Color fundus photograph · 45-degree field of view · 2352x1568
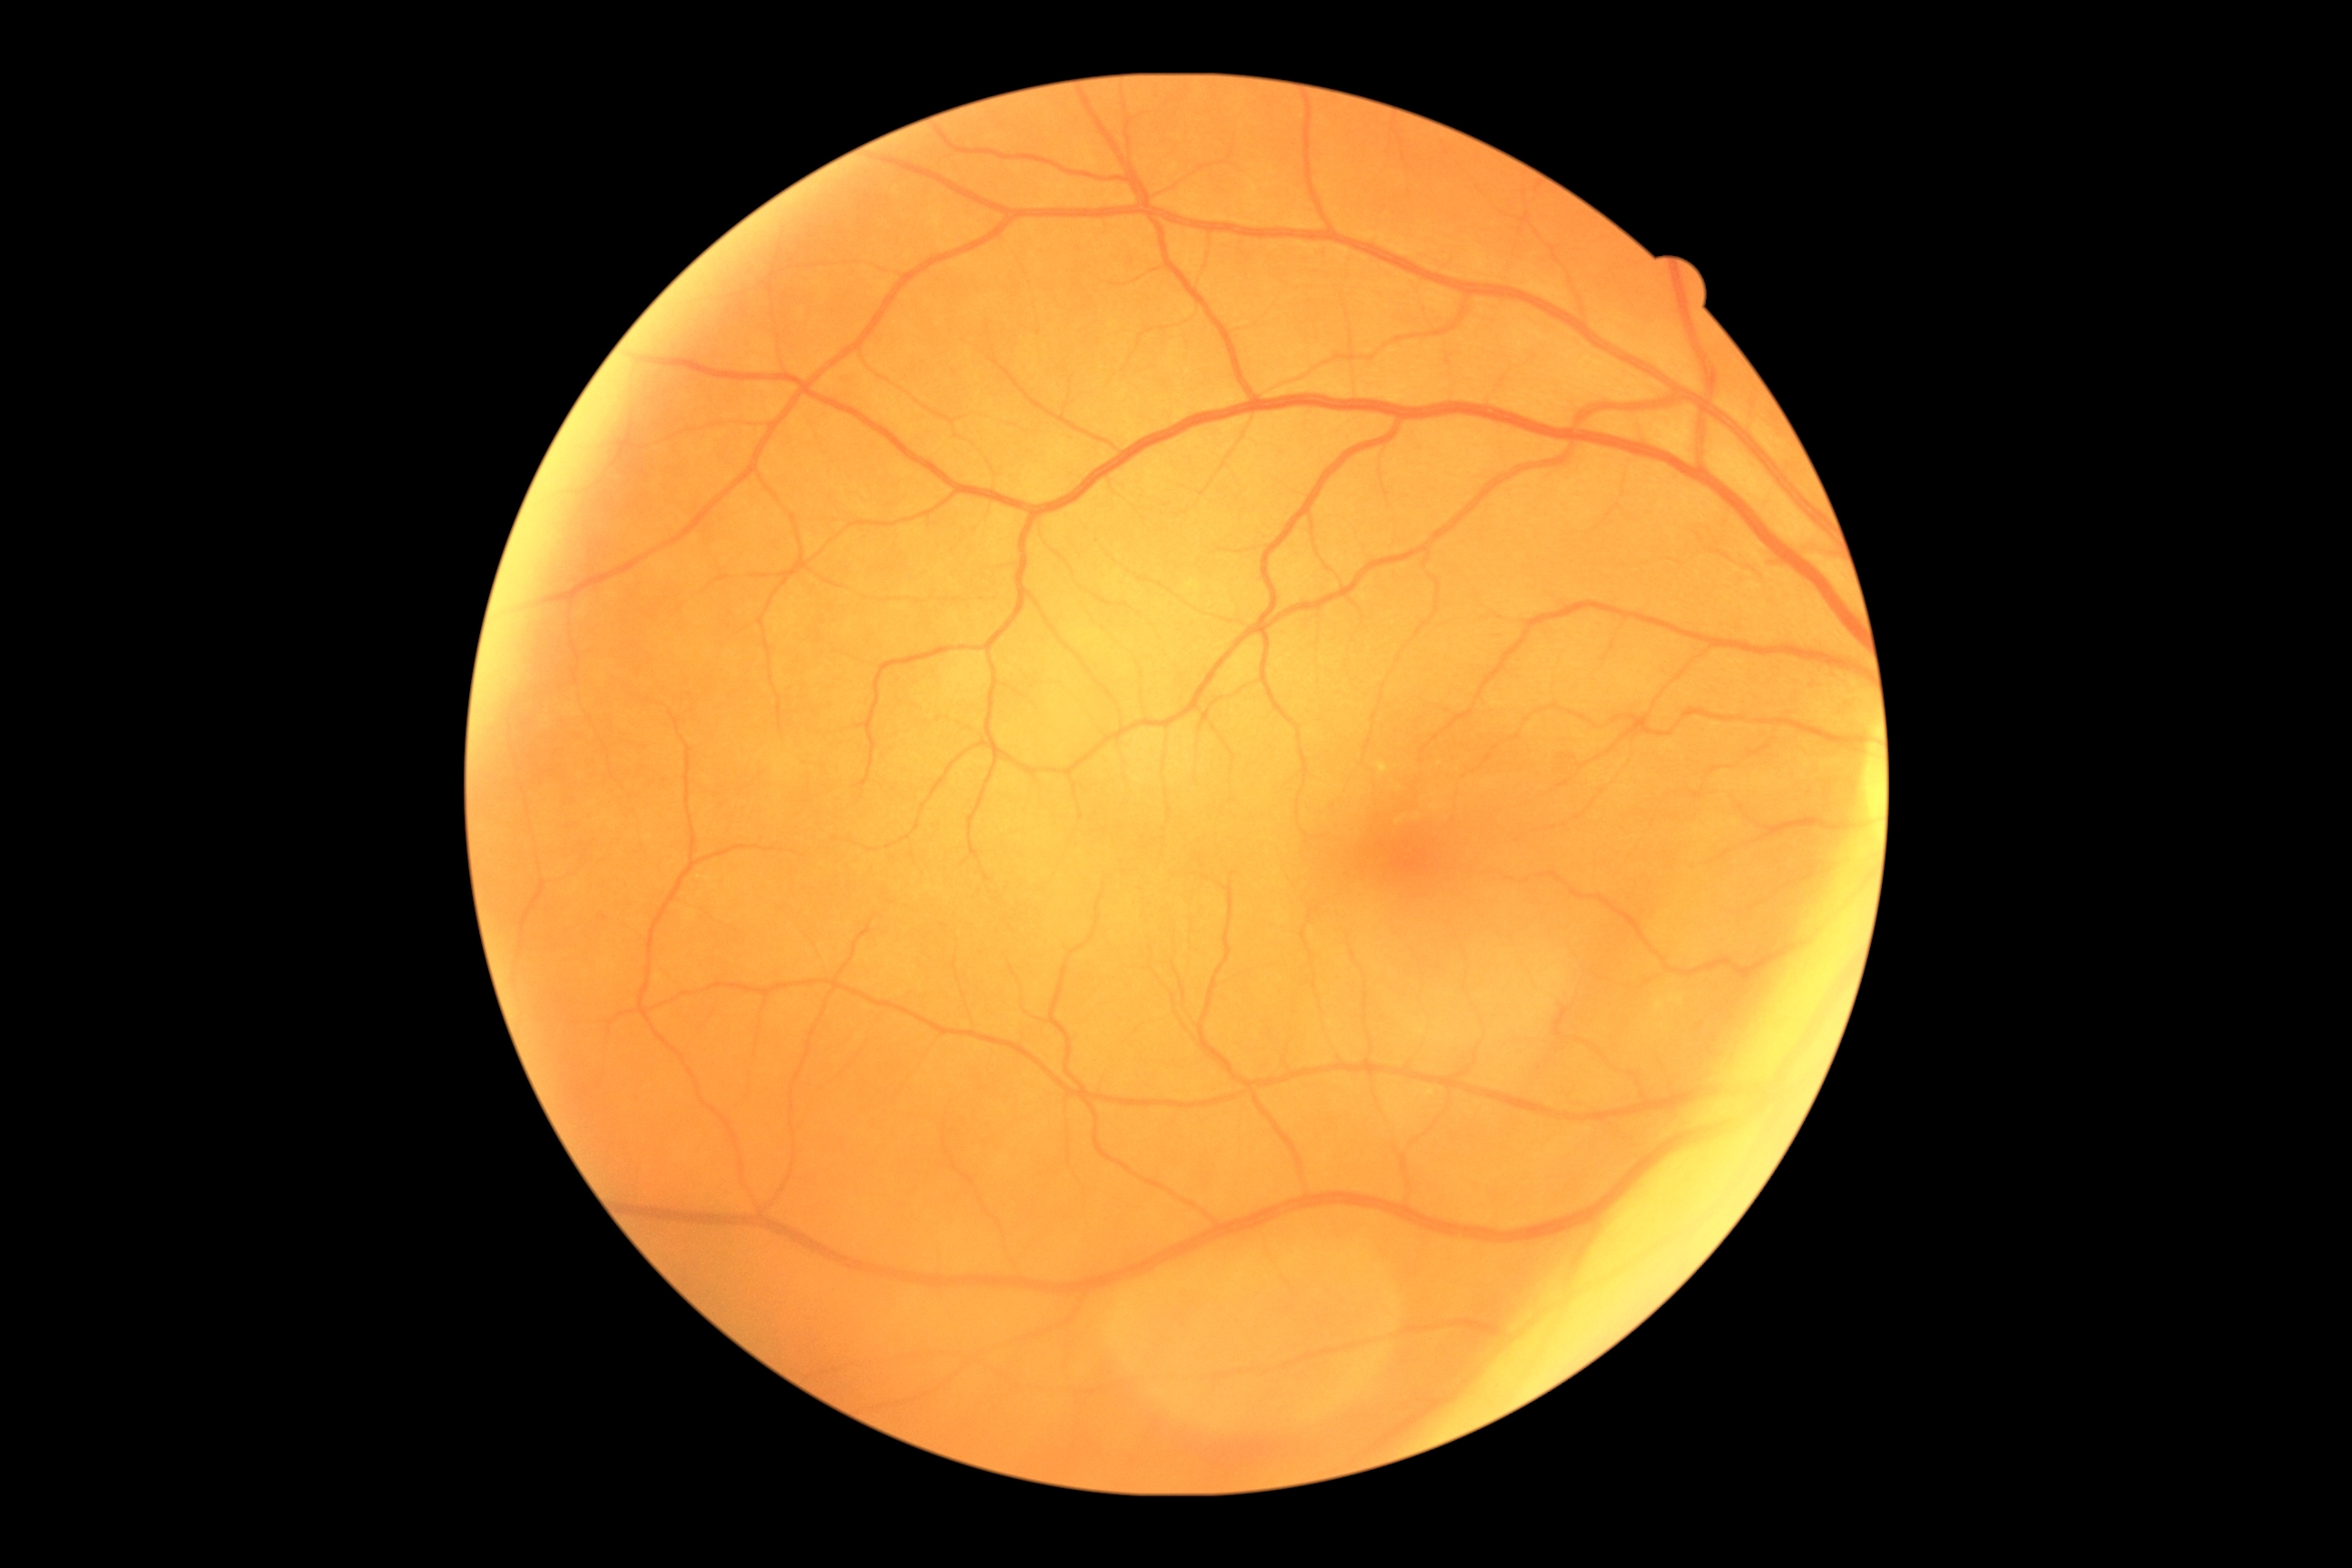 DR stage: grade 0 (no apparent retinopathy).